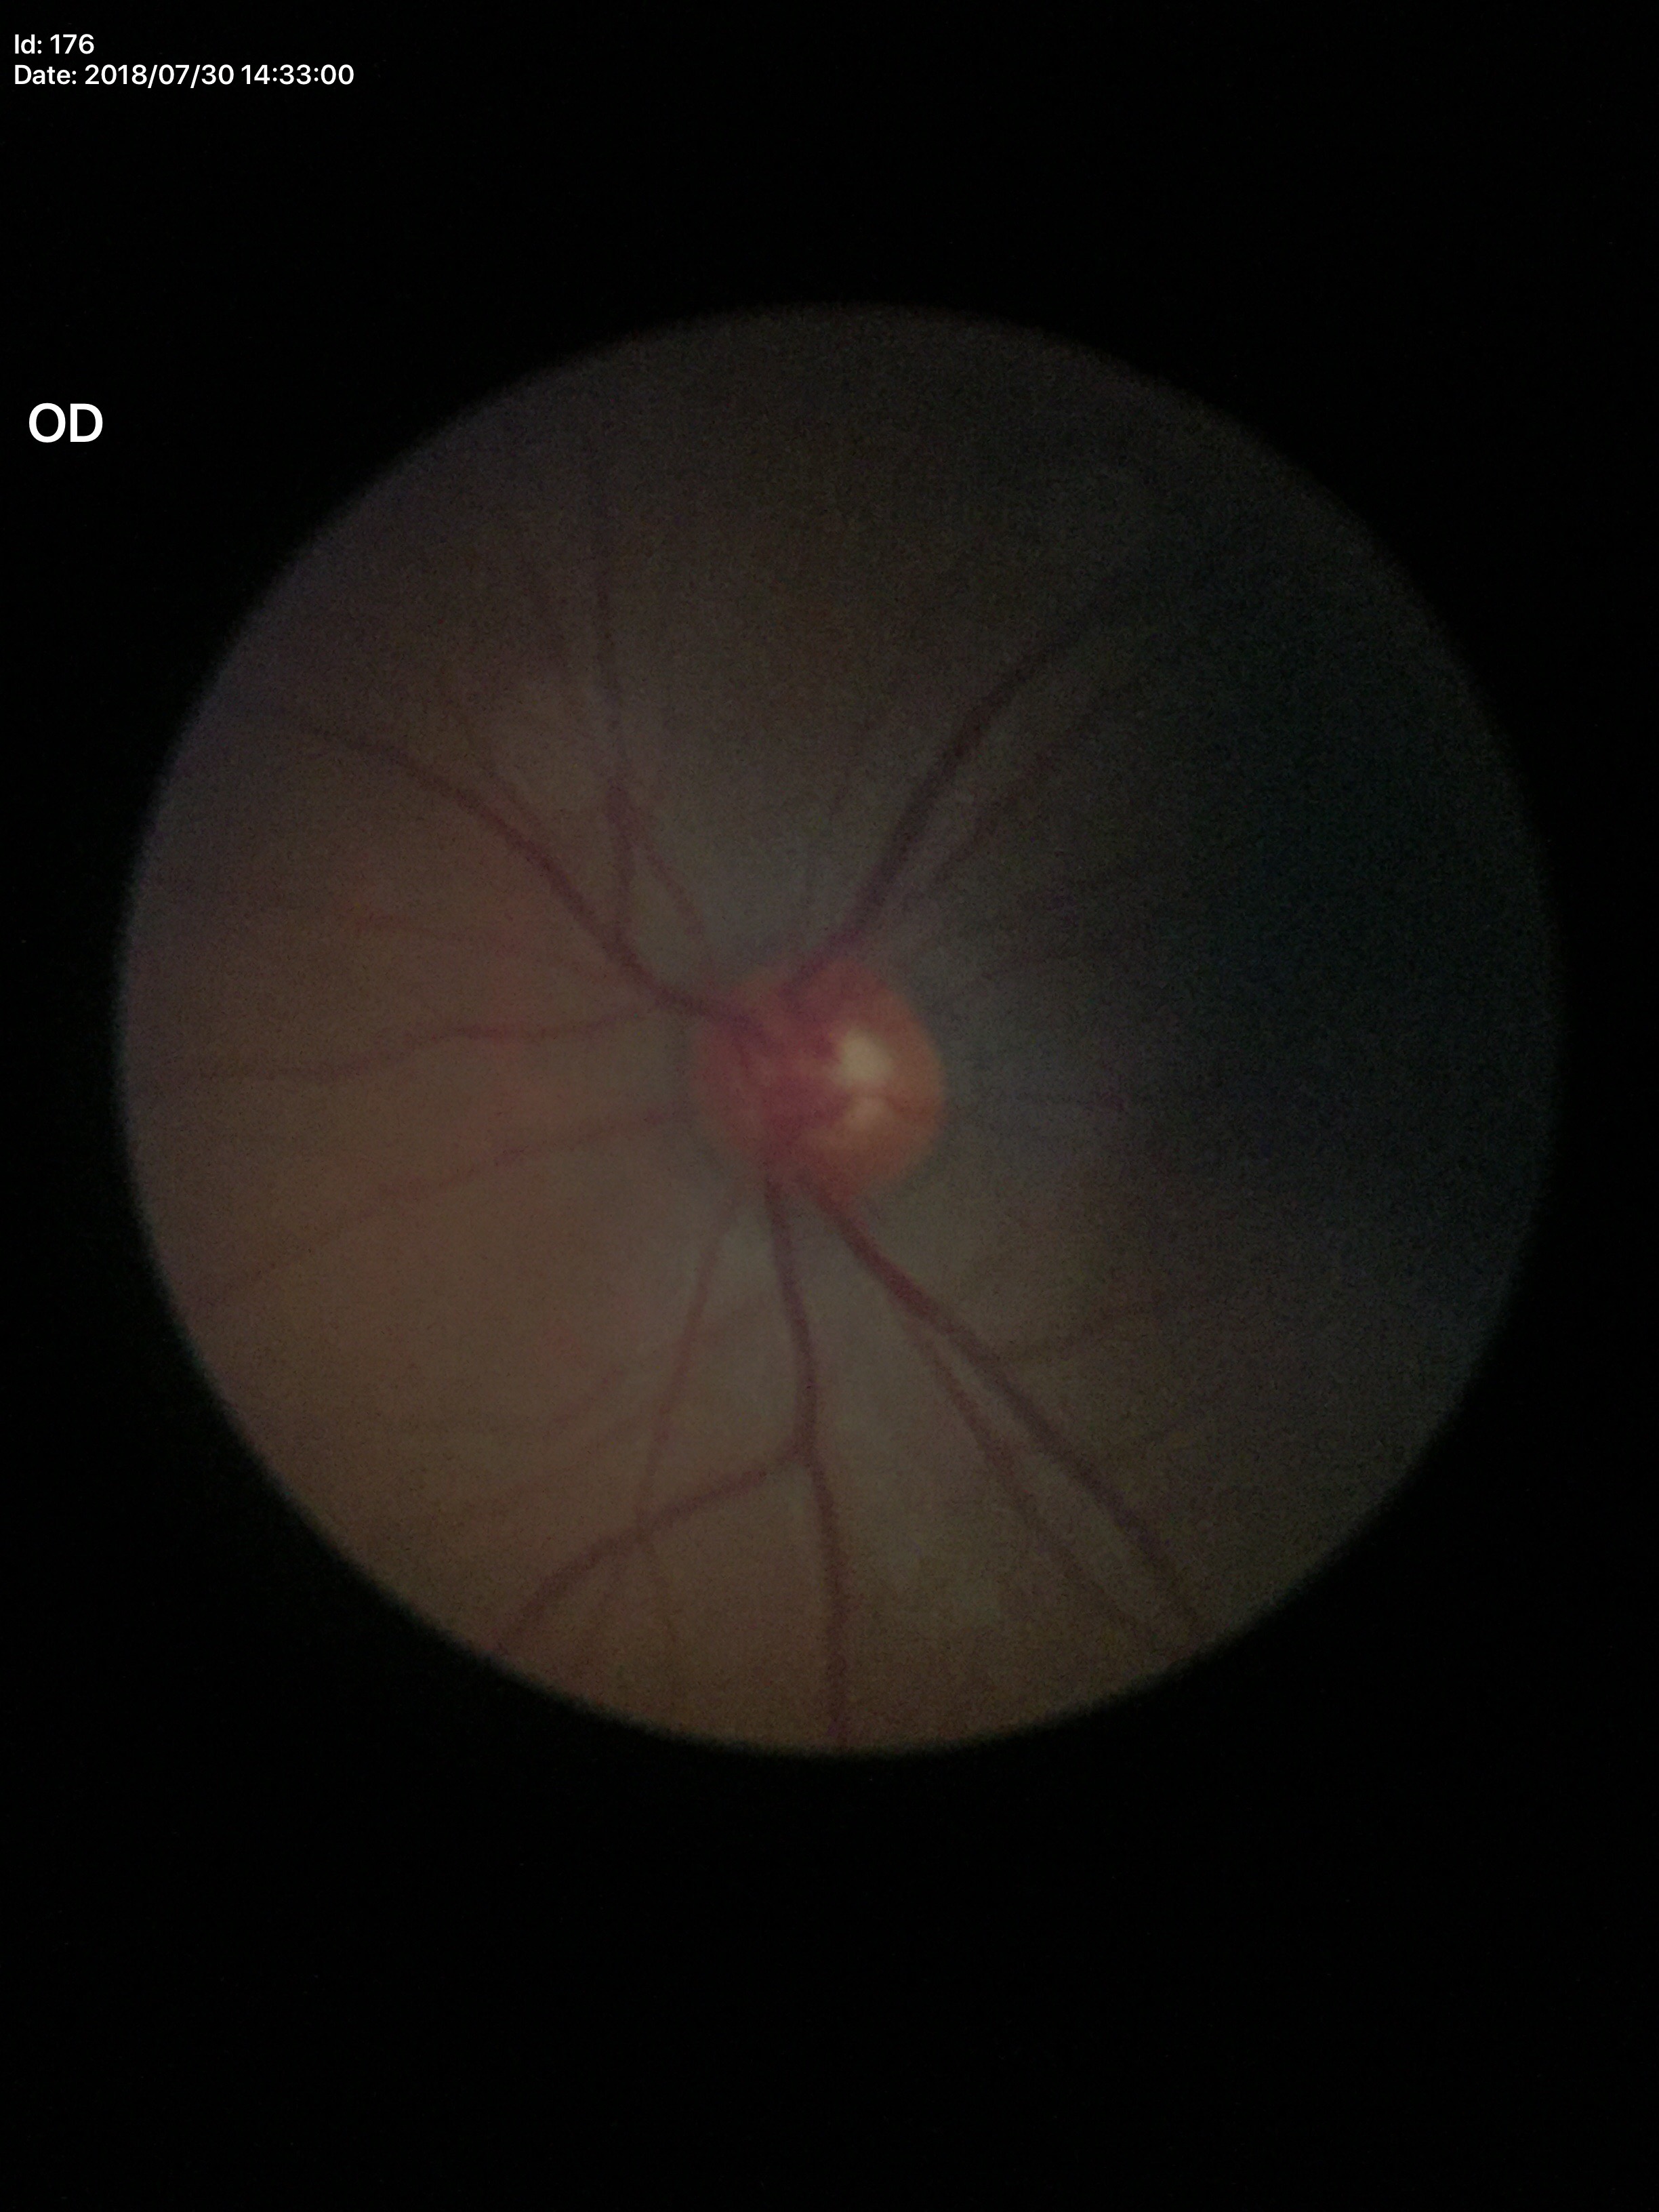

No signs of glaucoma. Vertical CDR: 0.55. Horizontal C/D ratio is 0.53.